1932 by 1916 pixels.
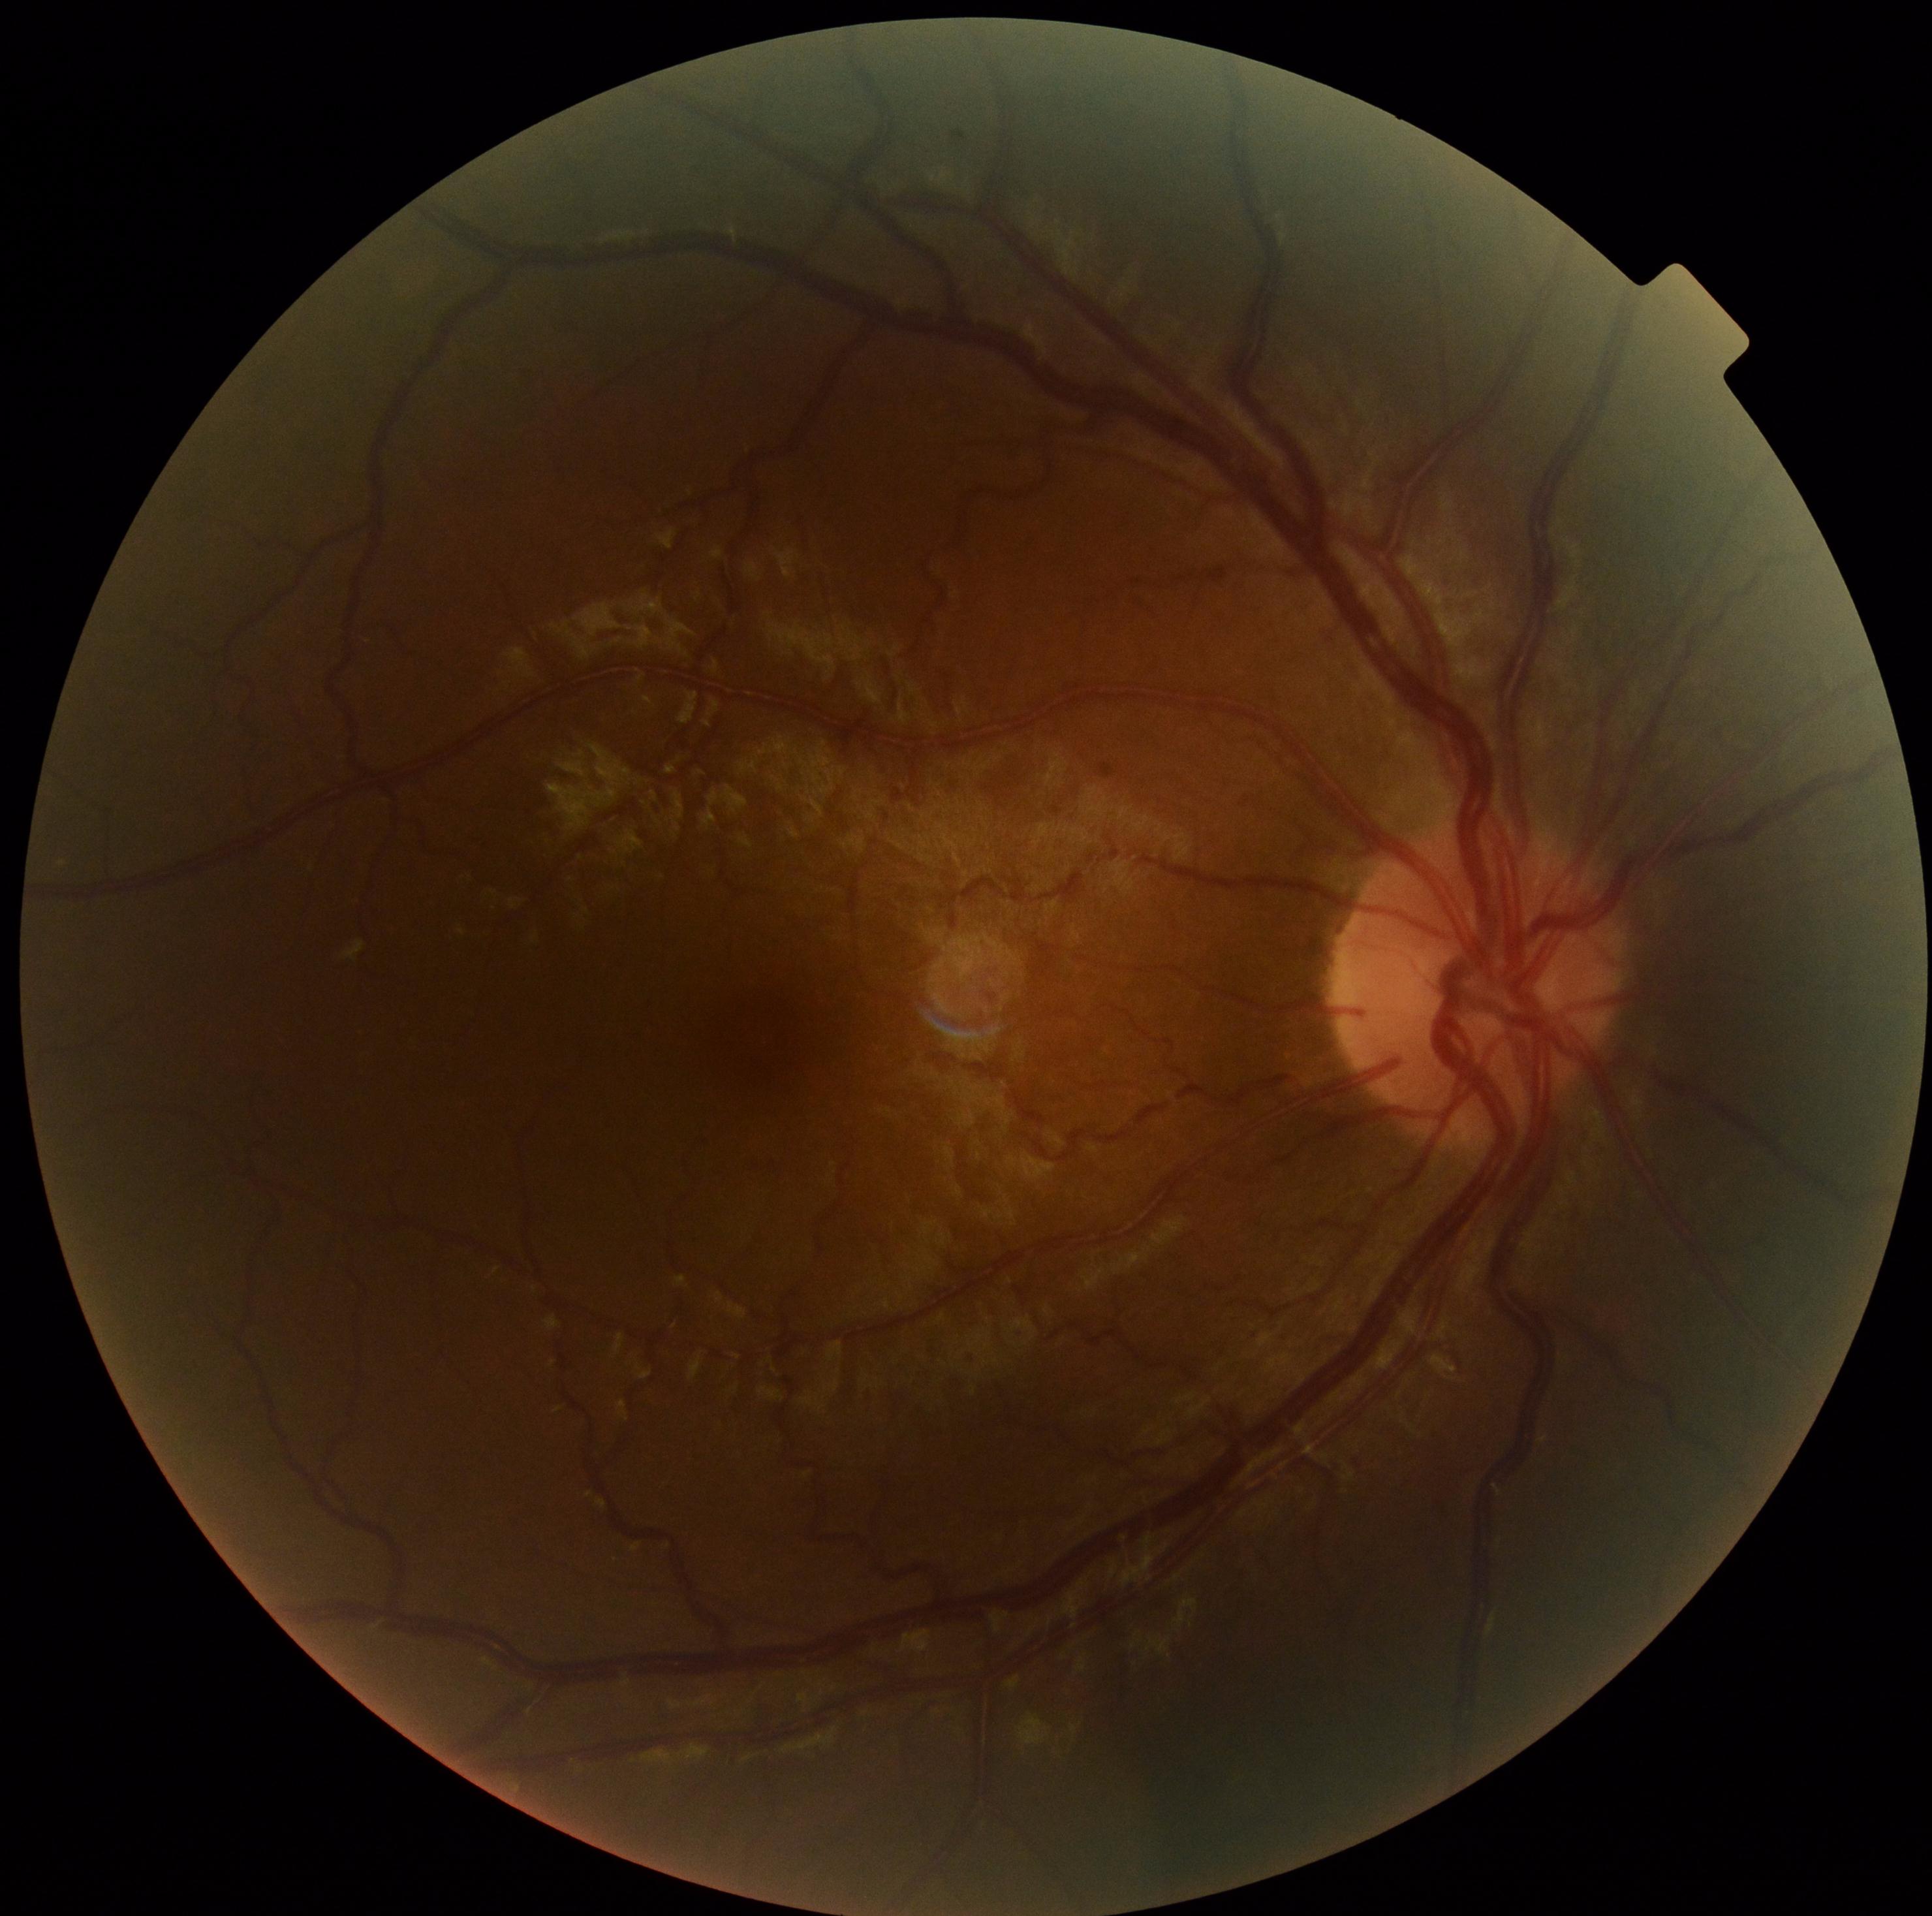
DR grade: no apparent diabetic retinopathy (0).